45-degree field of view · 848x848px · modified Davis grading · posterior pole photograph · no pharmacologic dilation · camera: NIDEK AFC-230.
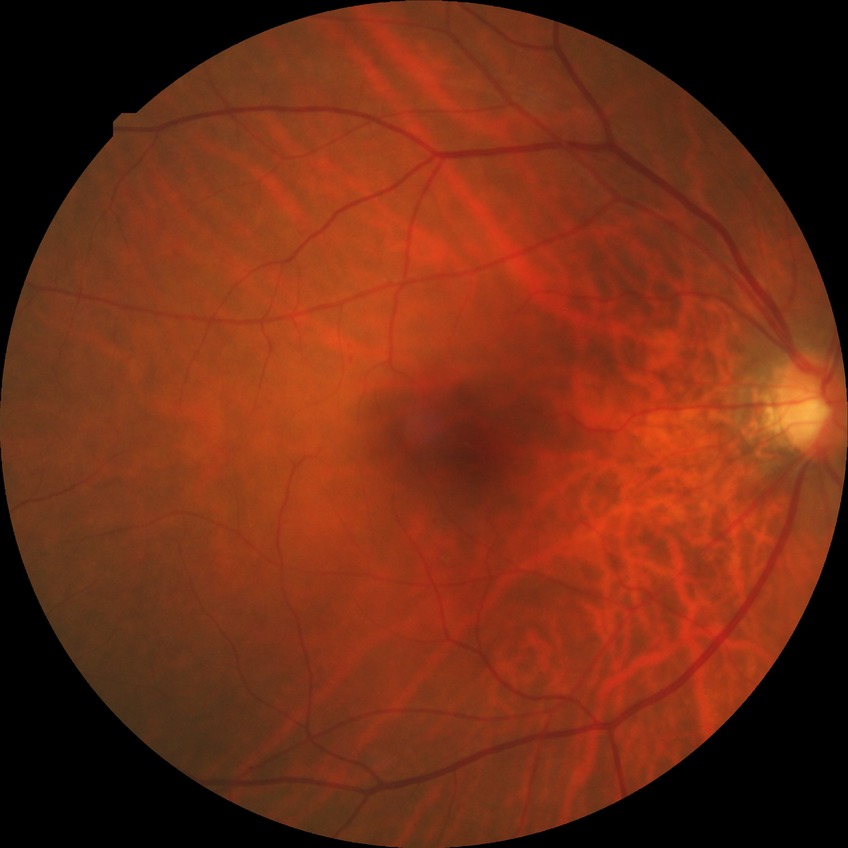 diabetic retinopathy (DR): NDR (no diabetic retinopathy).